Image size 1932x1916 — 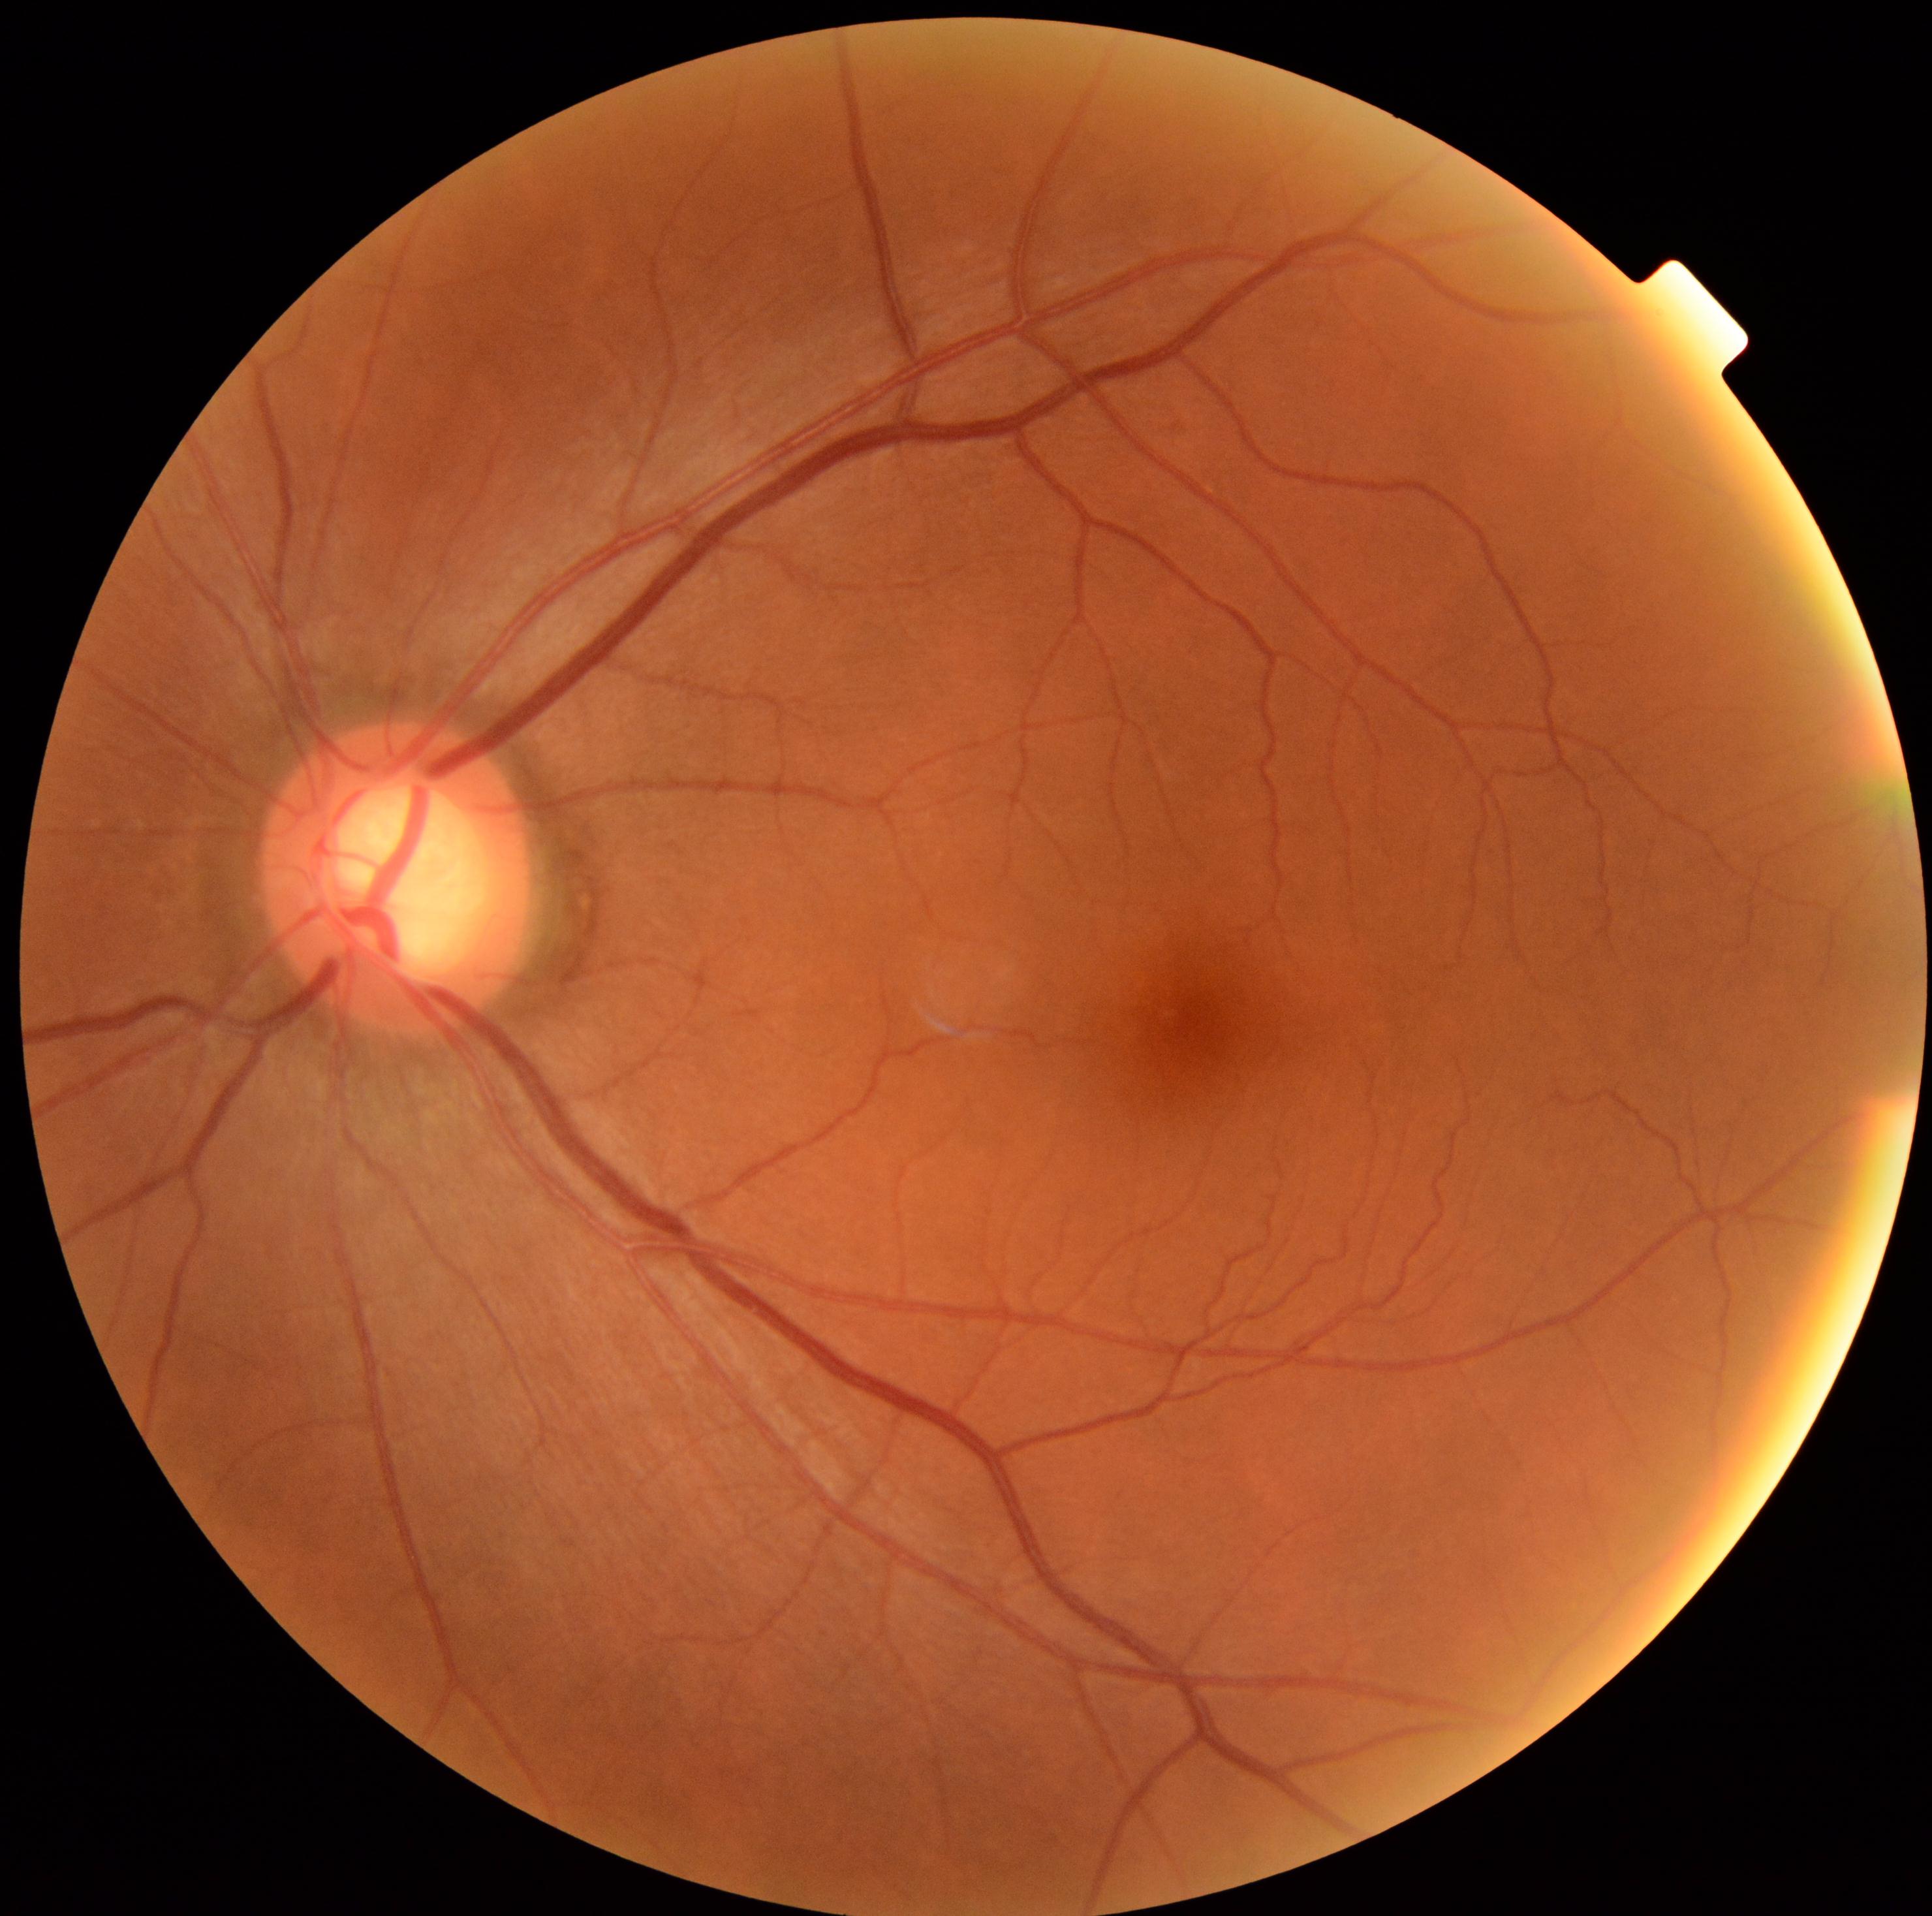

DR@0.